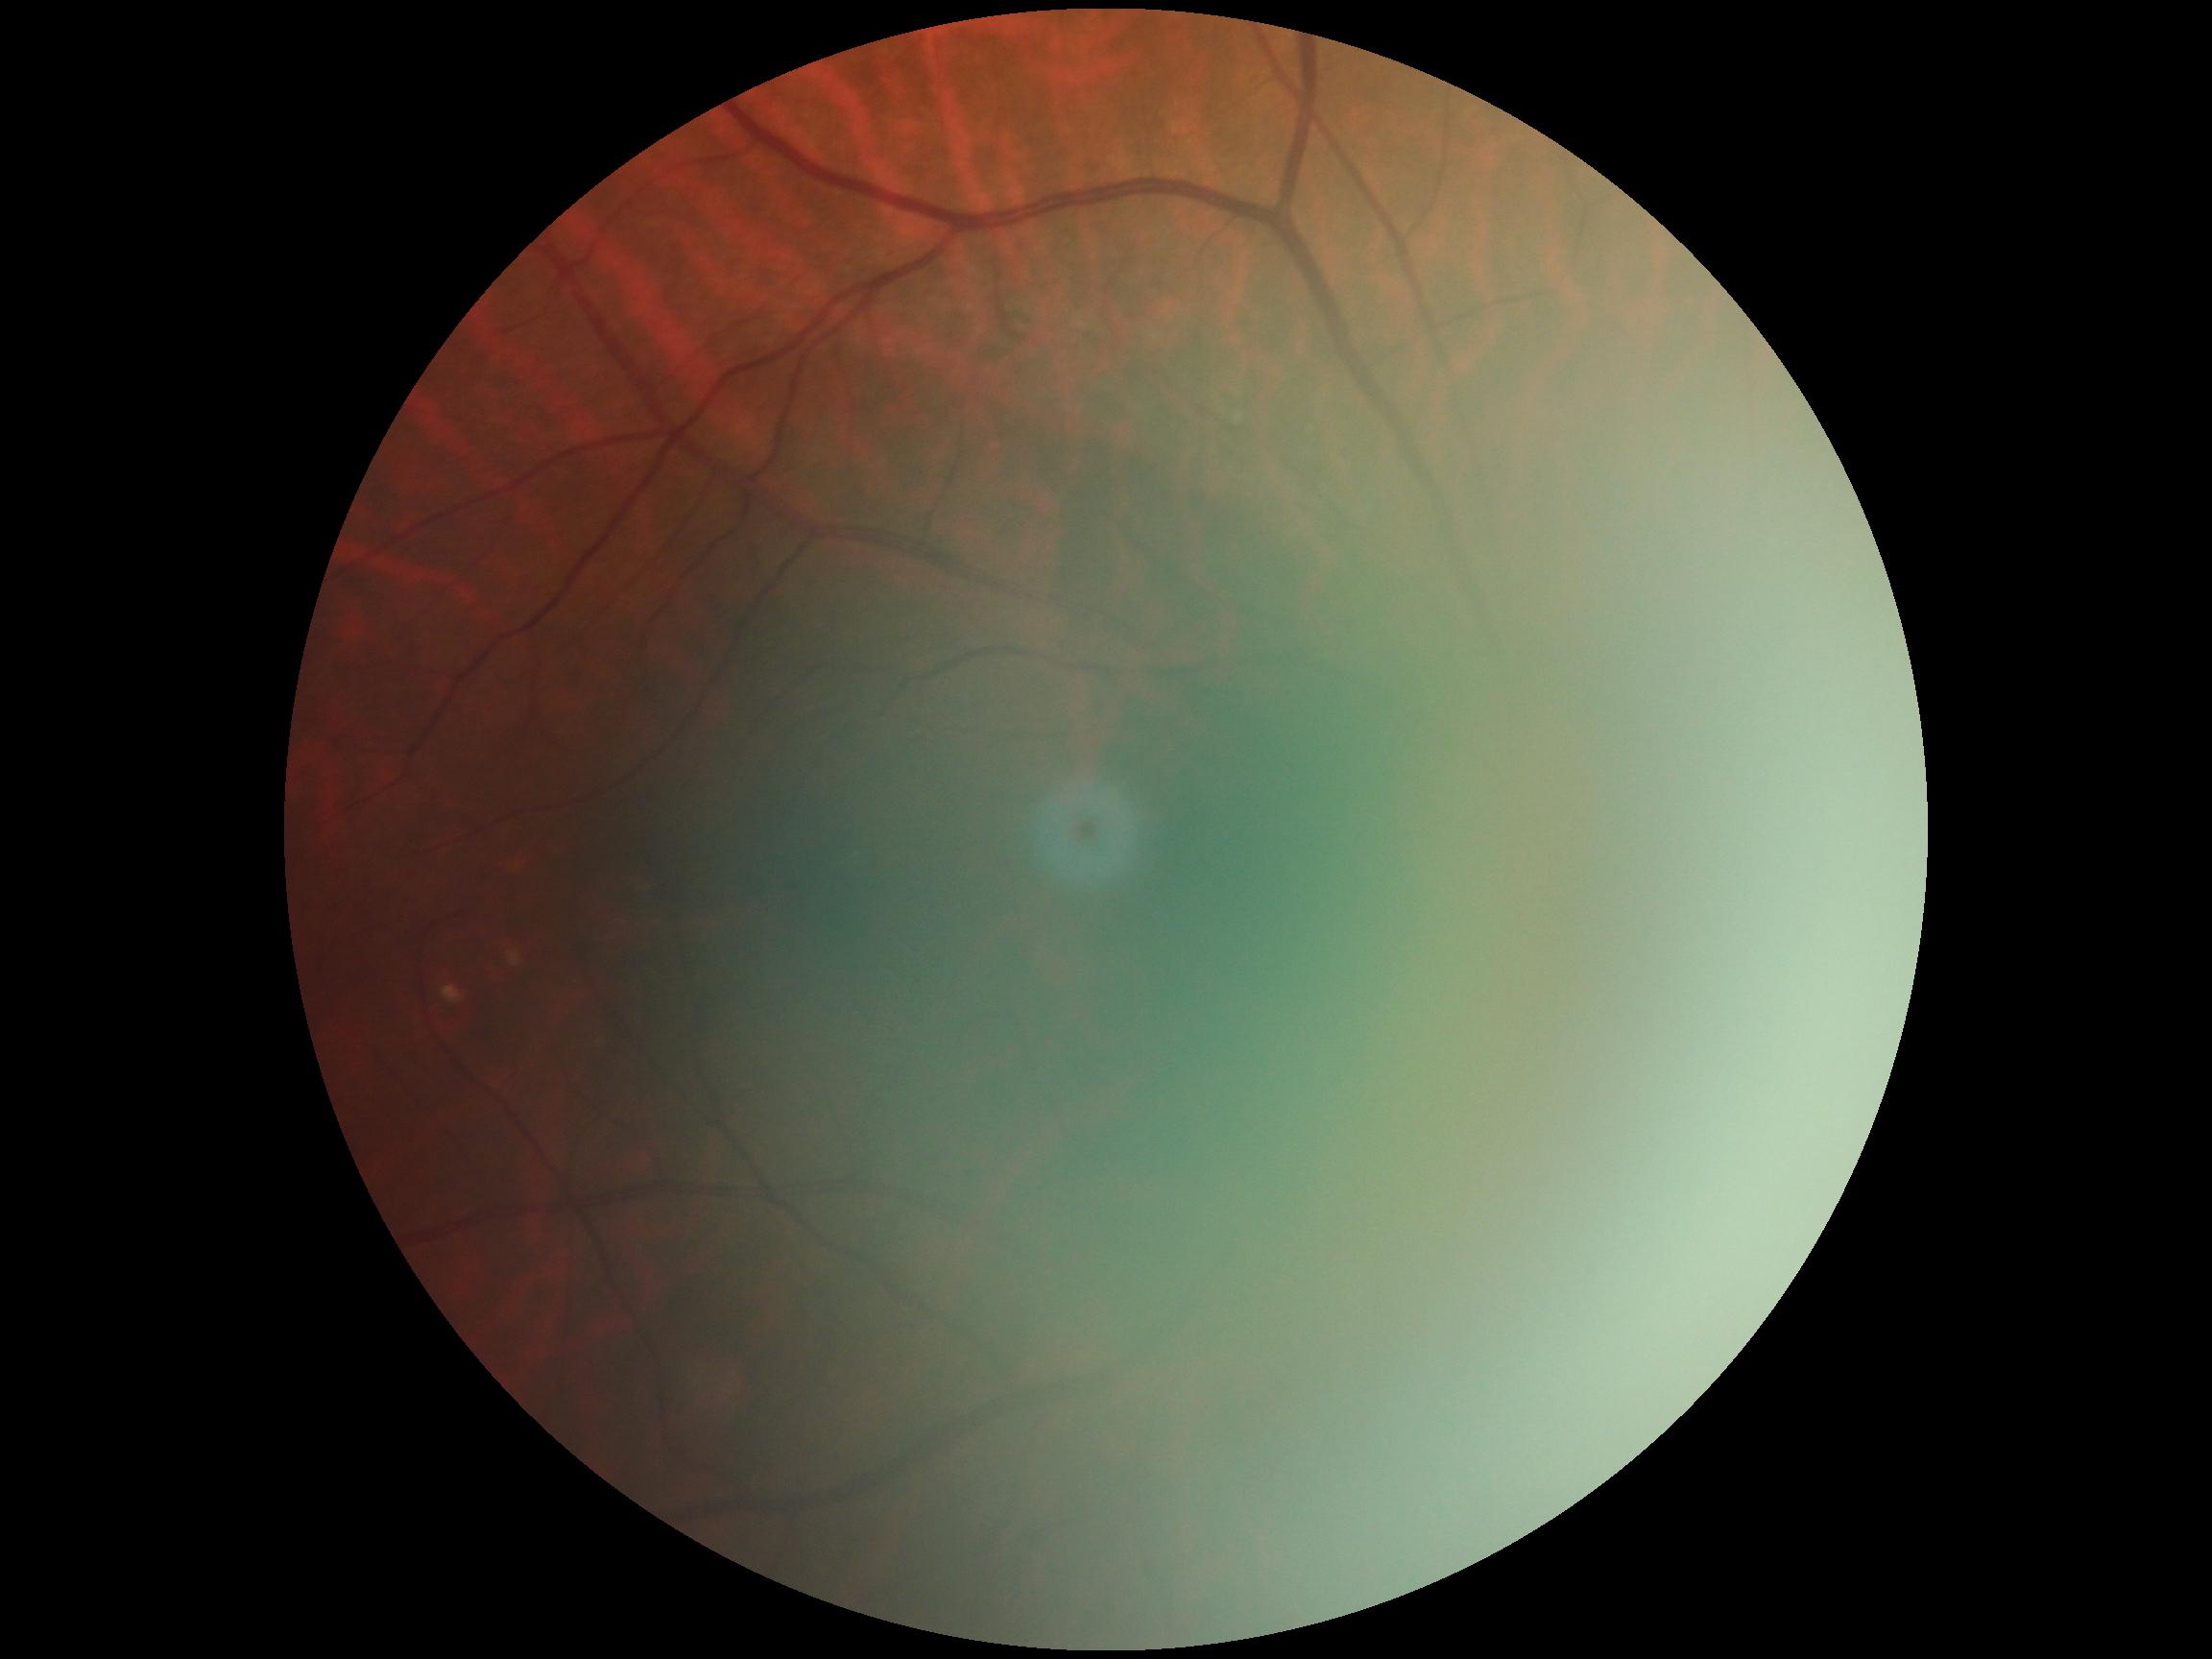

* diabetic retinopathy (DR) — ungradable
* image quality — below grading threshold